45 degree fundus photograph.
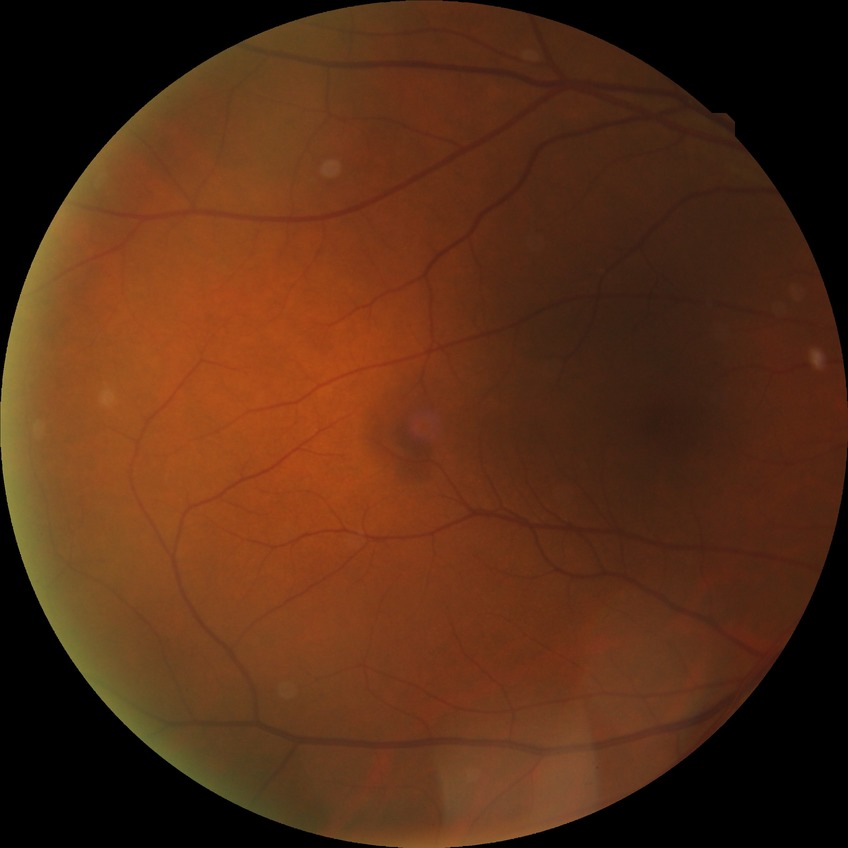
Diabetic retinopathy (DR): SDR (simple diabetic retinopathy).